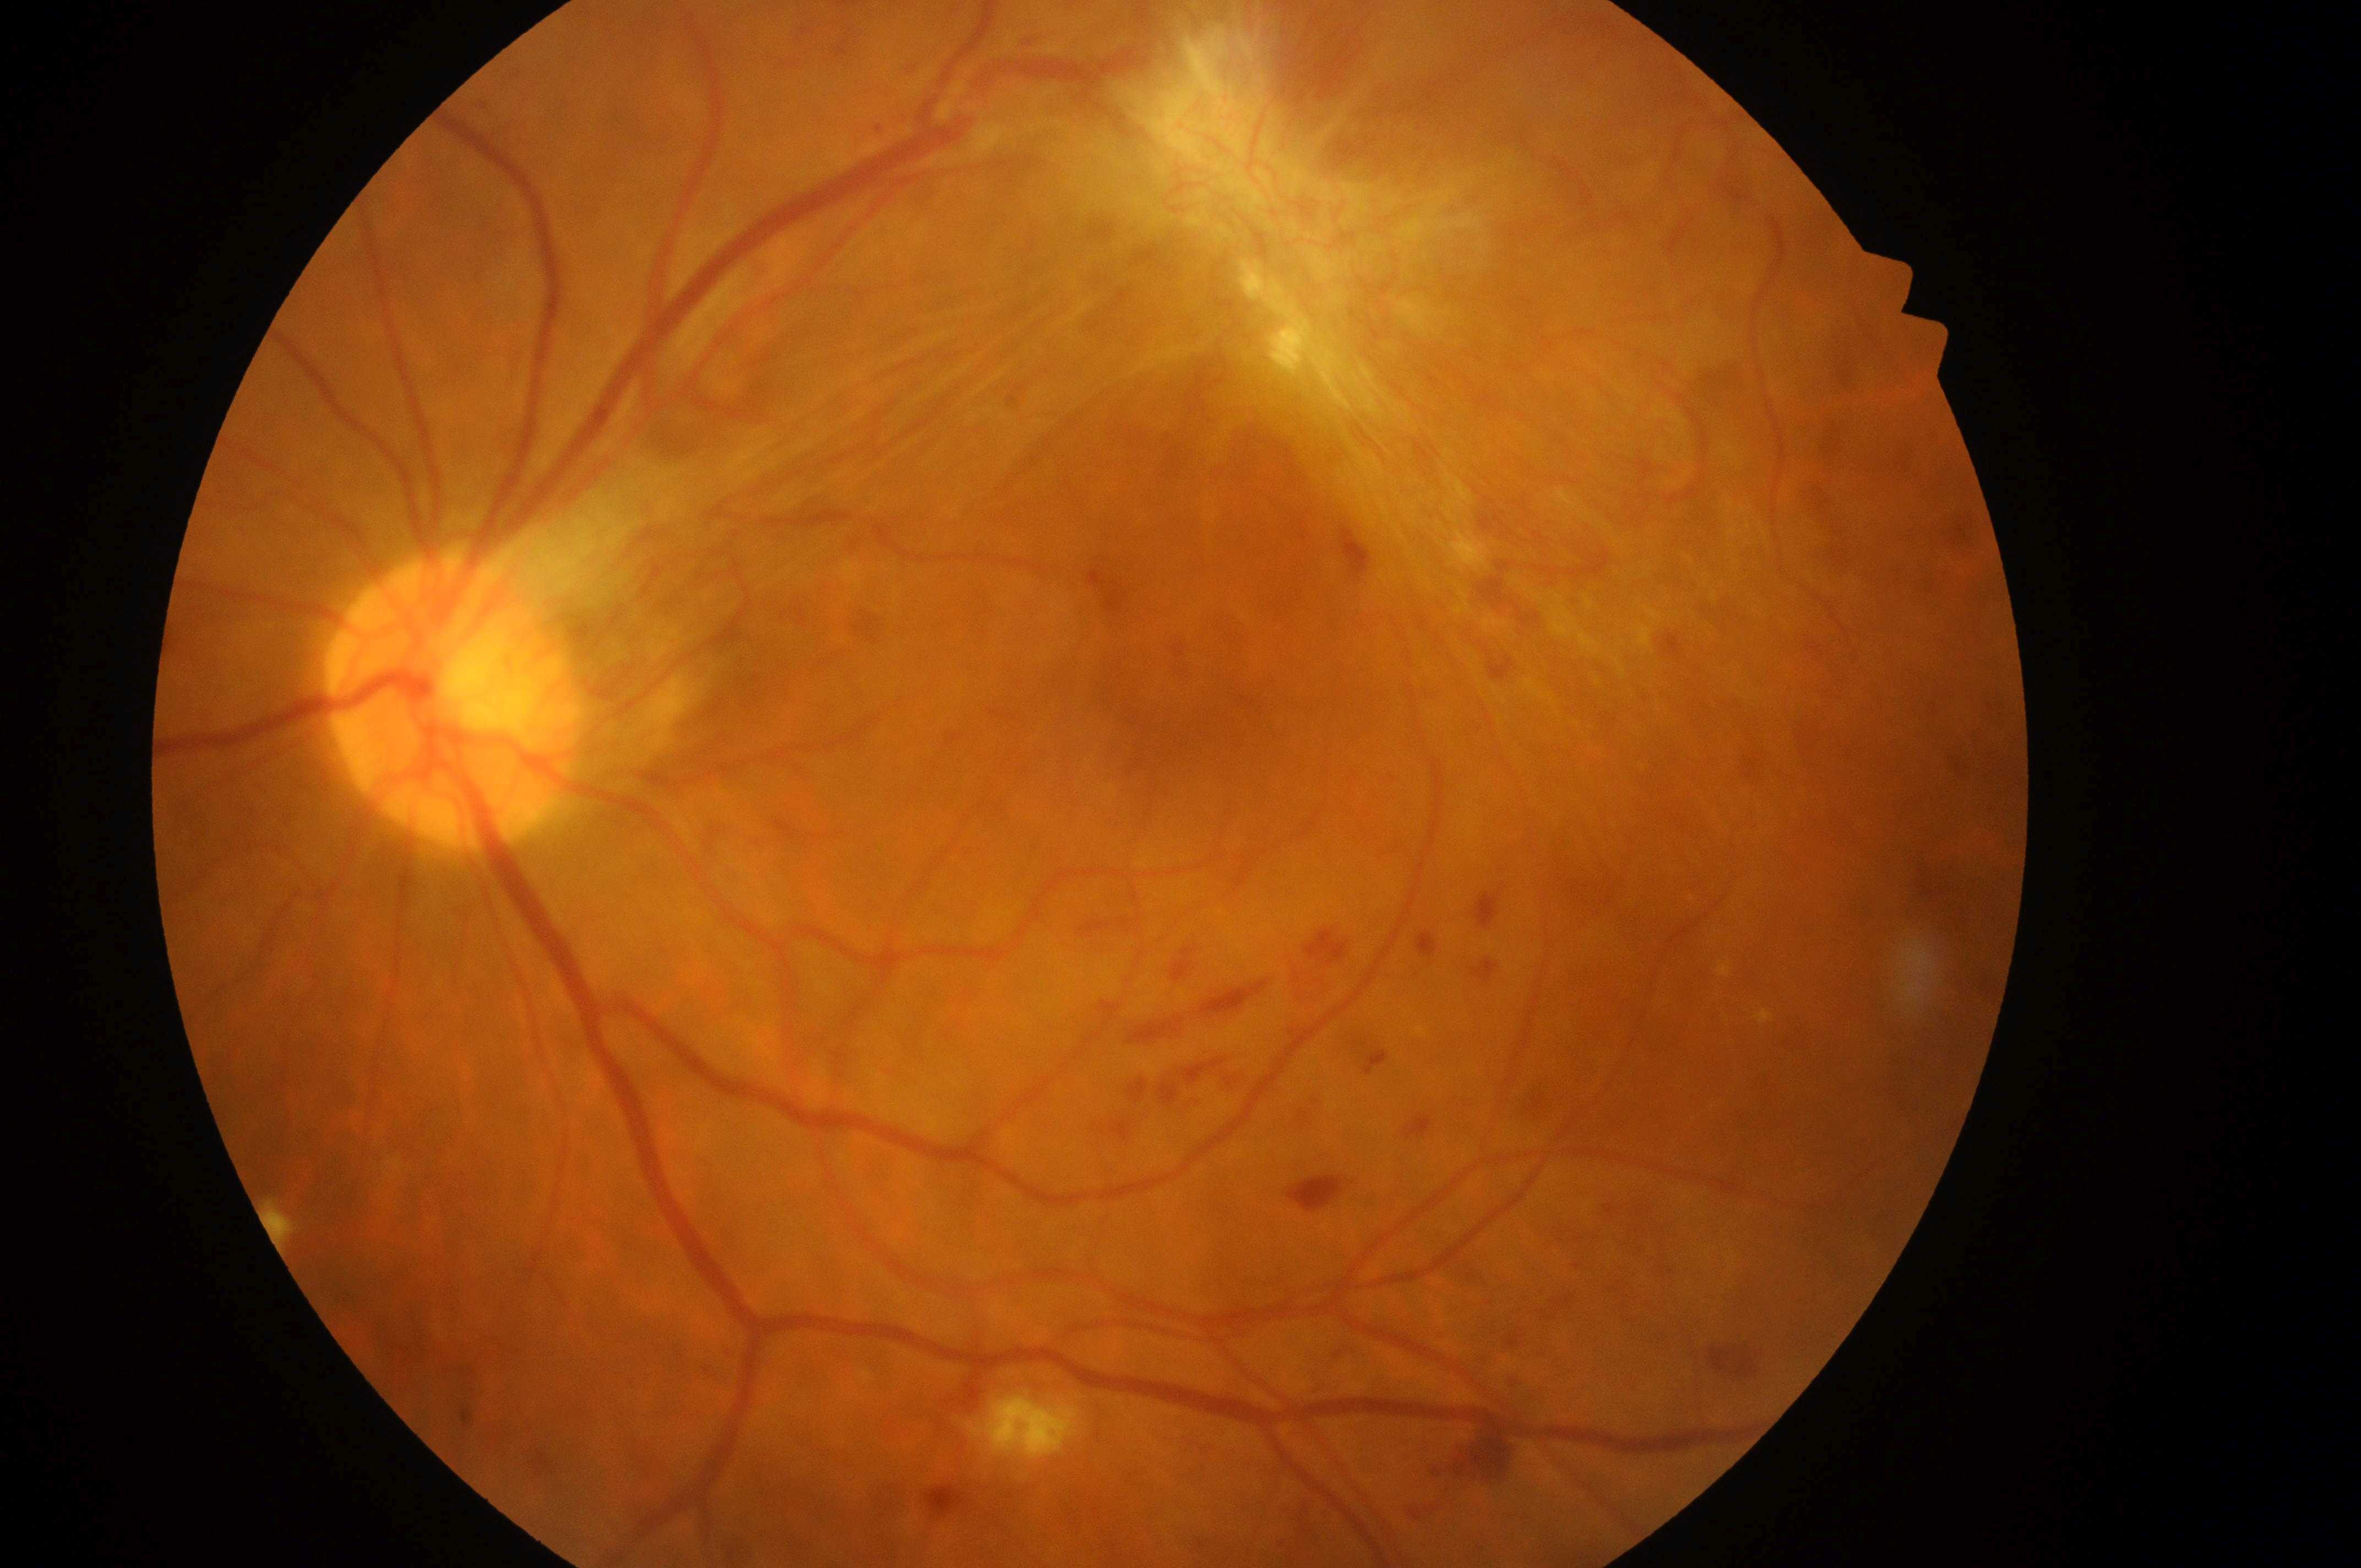

Diabetic macular edema is 1. This is the left eye. The fovea is at 1200px, 662px. Optic disk: 455px, 707px. Retinopathy grade is 4.